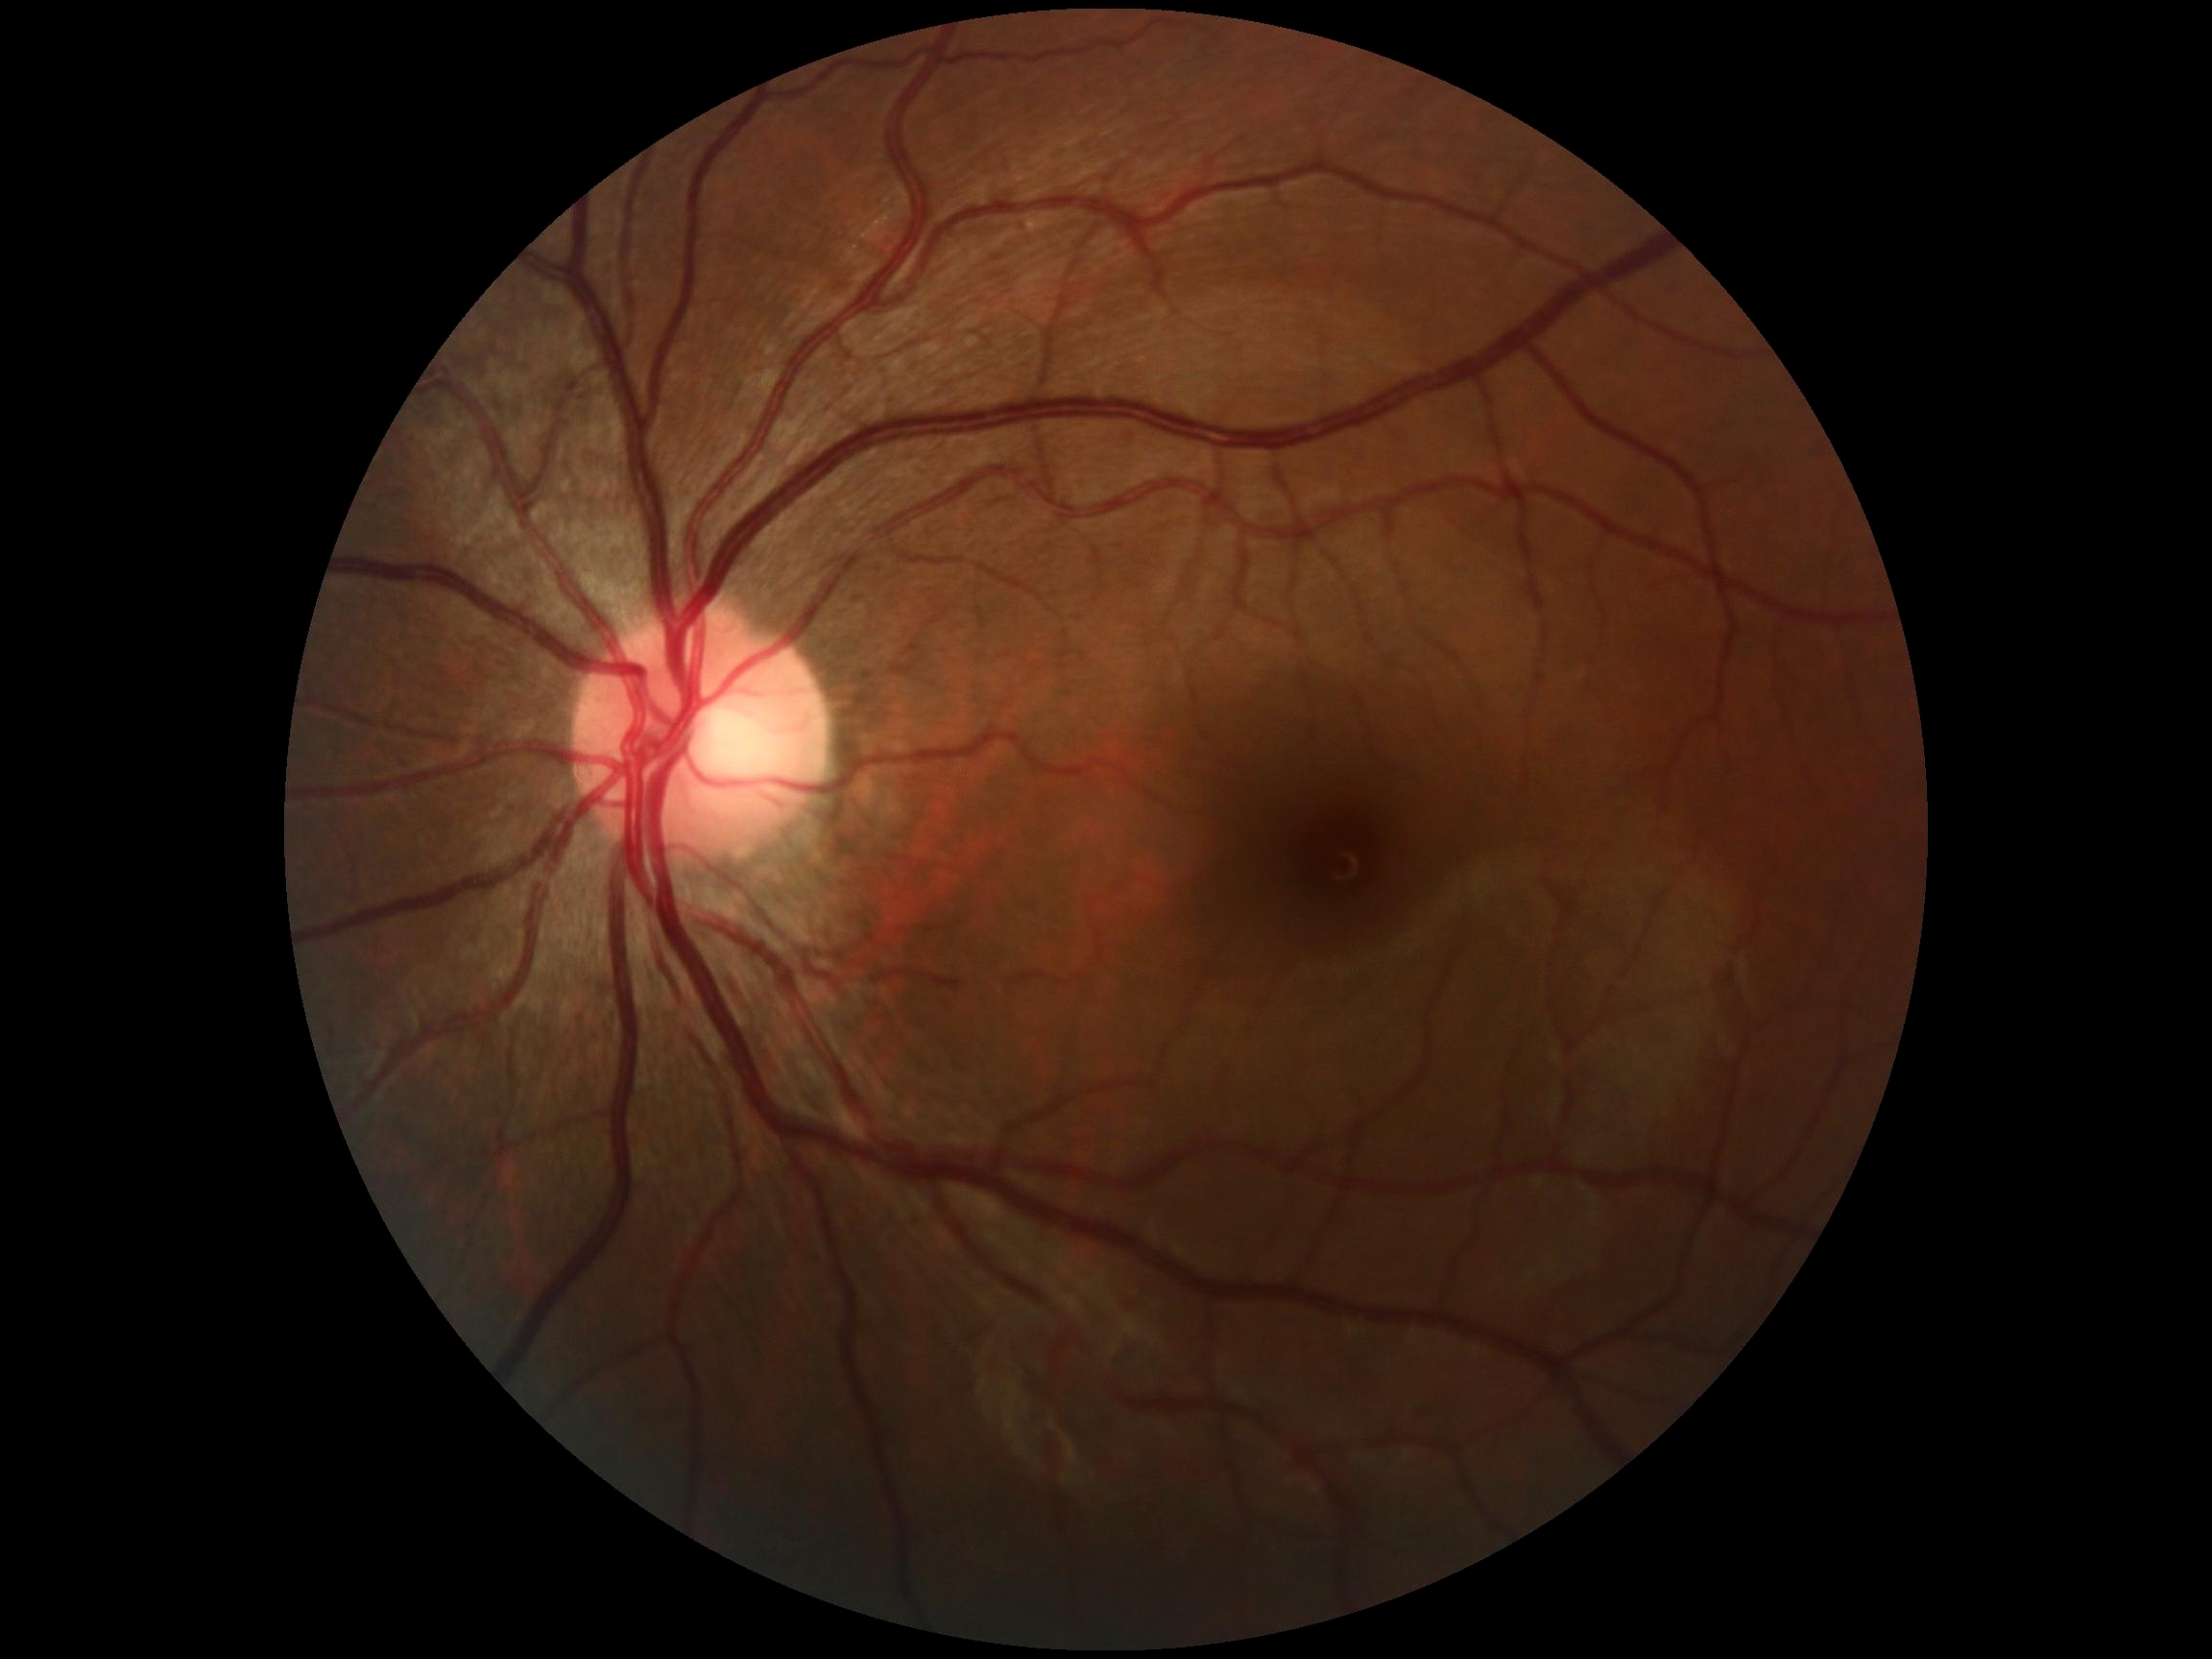
DR stage: 0/4 — no visible signs of diabetic retinopathy, DR impression: no DR findings.